640x480. Pediatric retinal photograph (wide-field) — 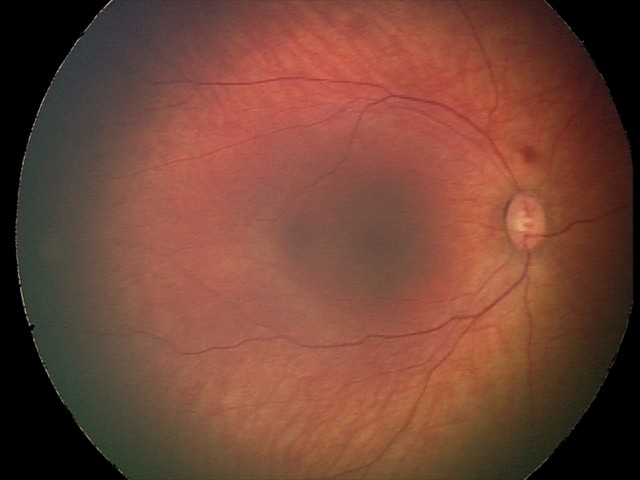 Diagnosis: retinal hemorrhages.